45° FOV
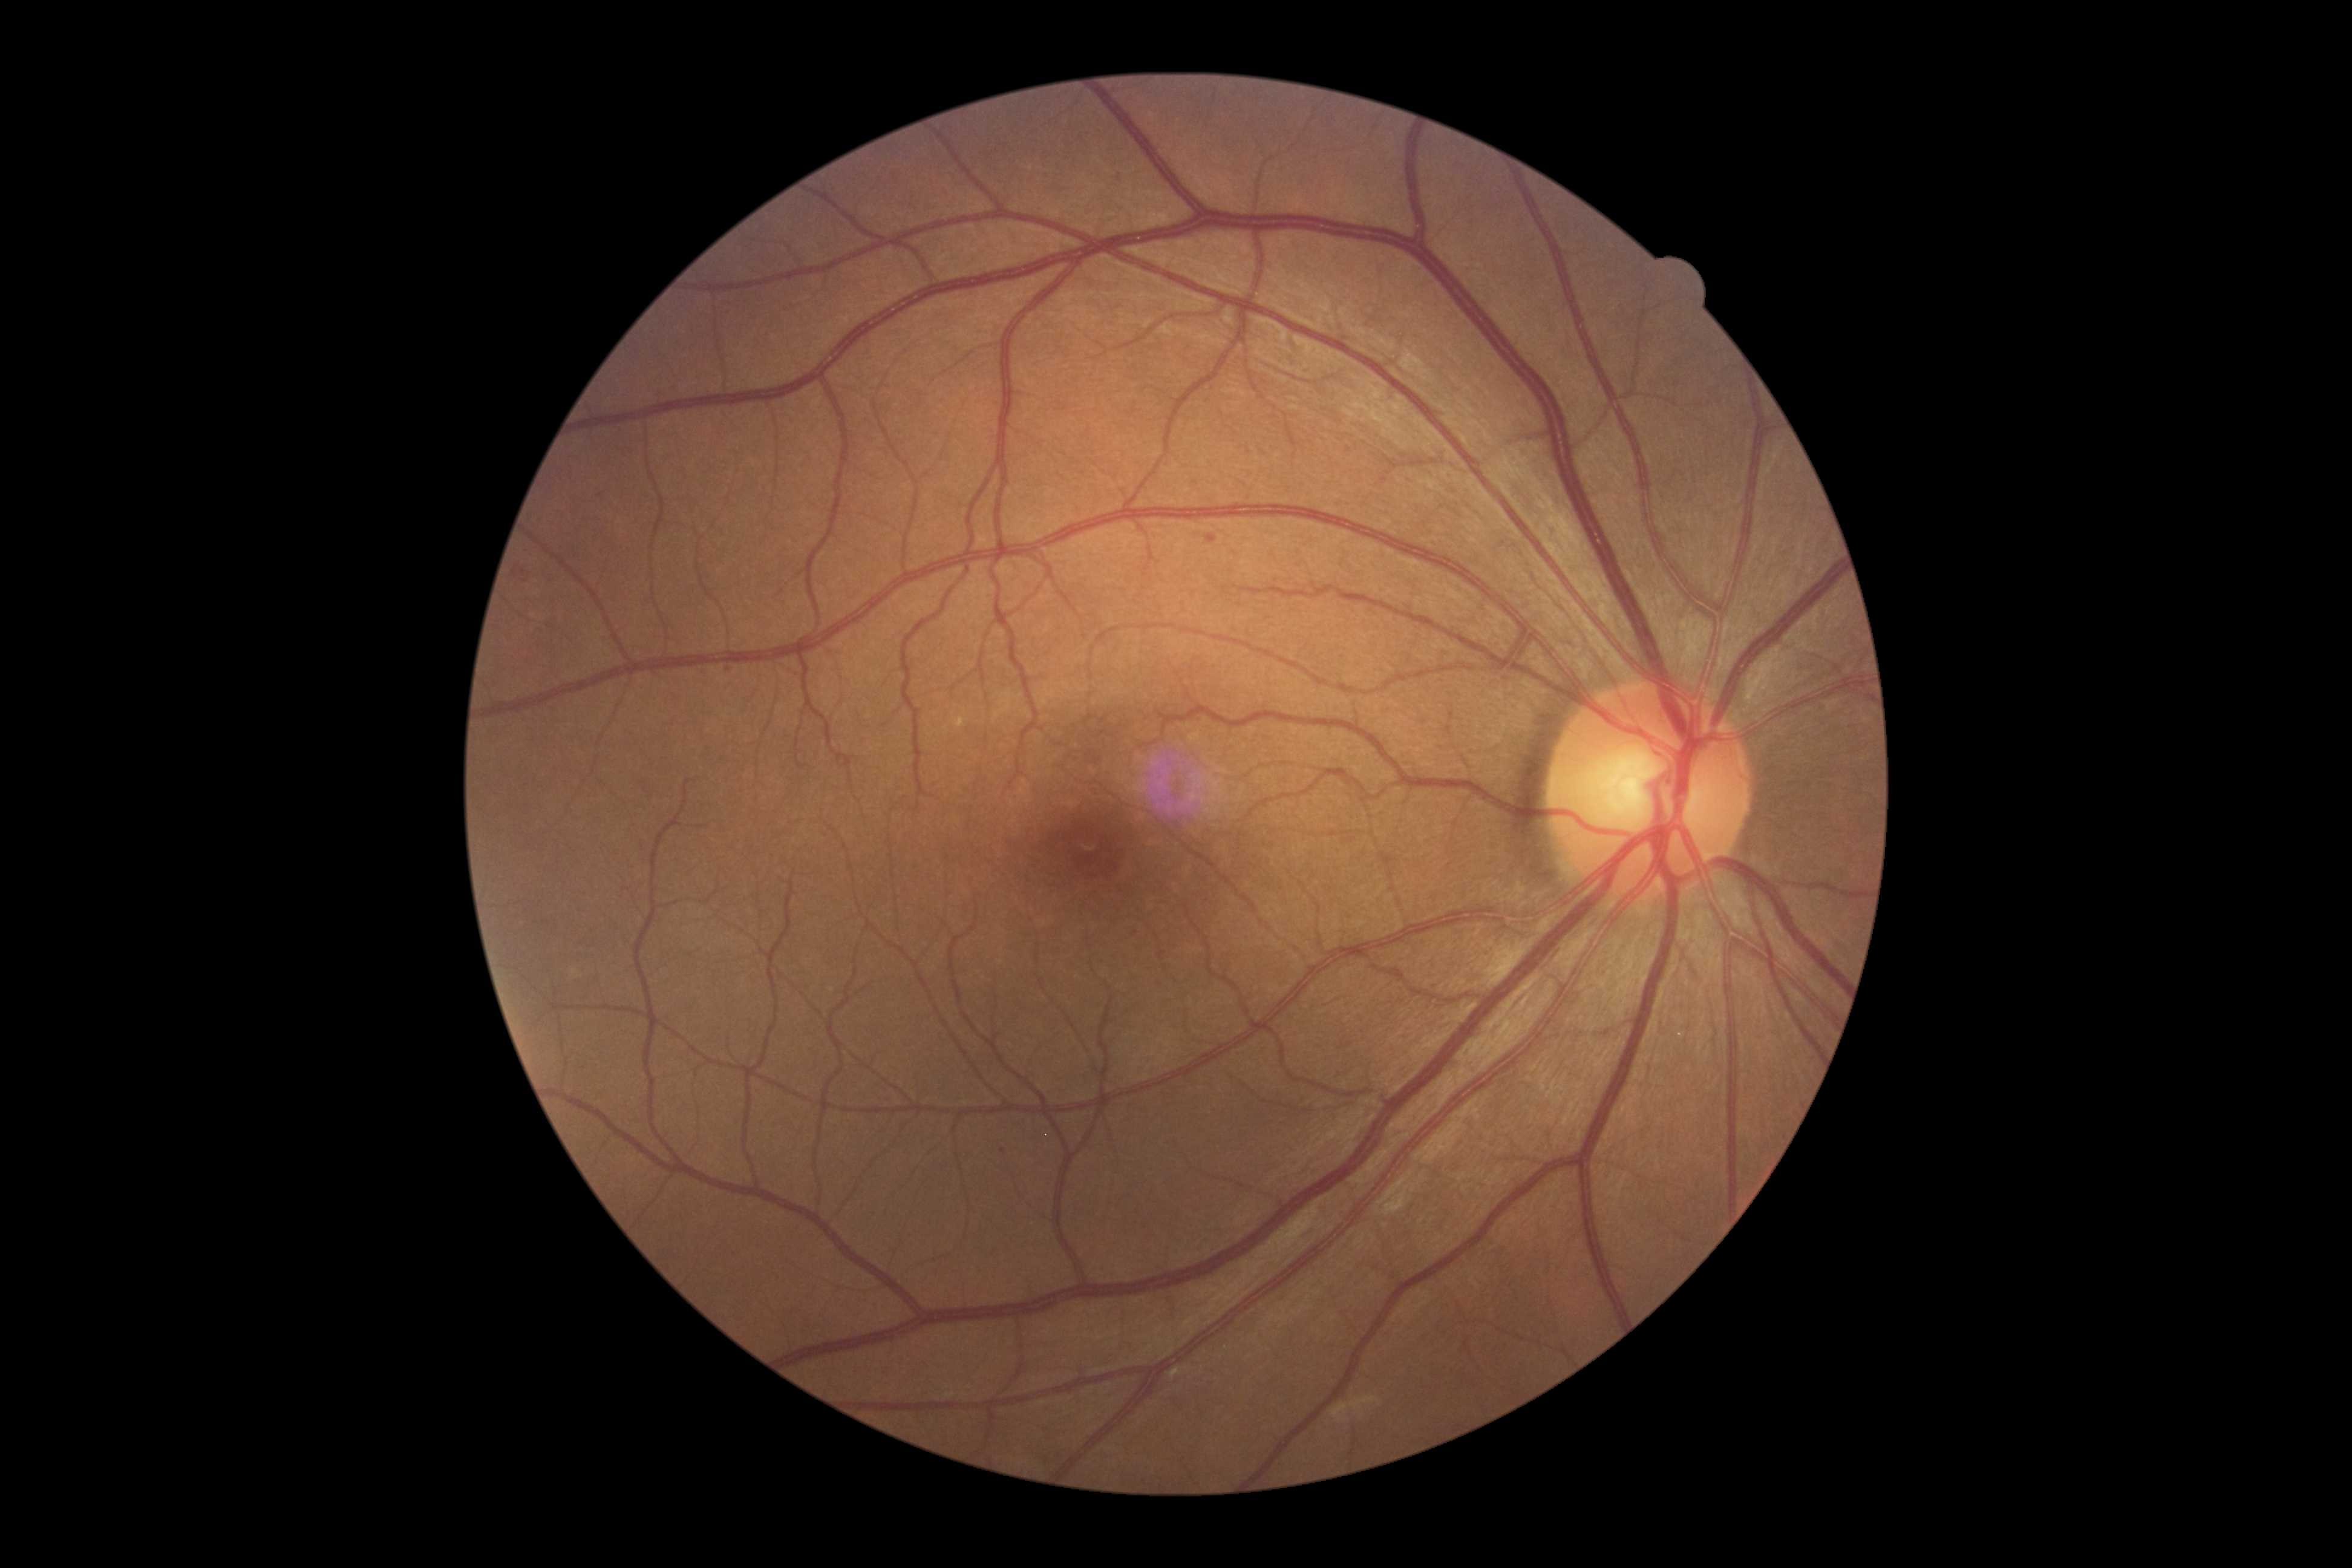
Findings:
• retinopathy grade — moderate NPDR (2)
• DR class — non-proliferative diabetic retinopathy